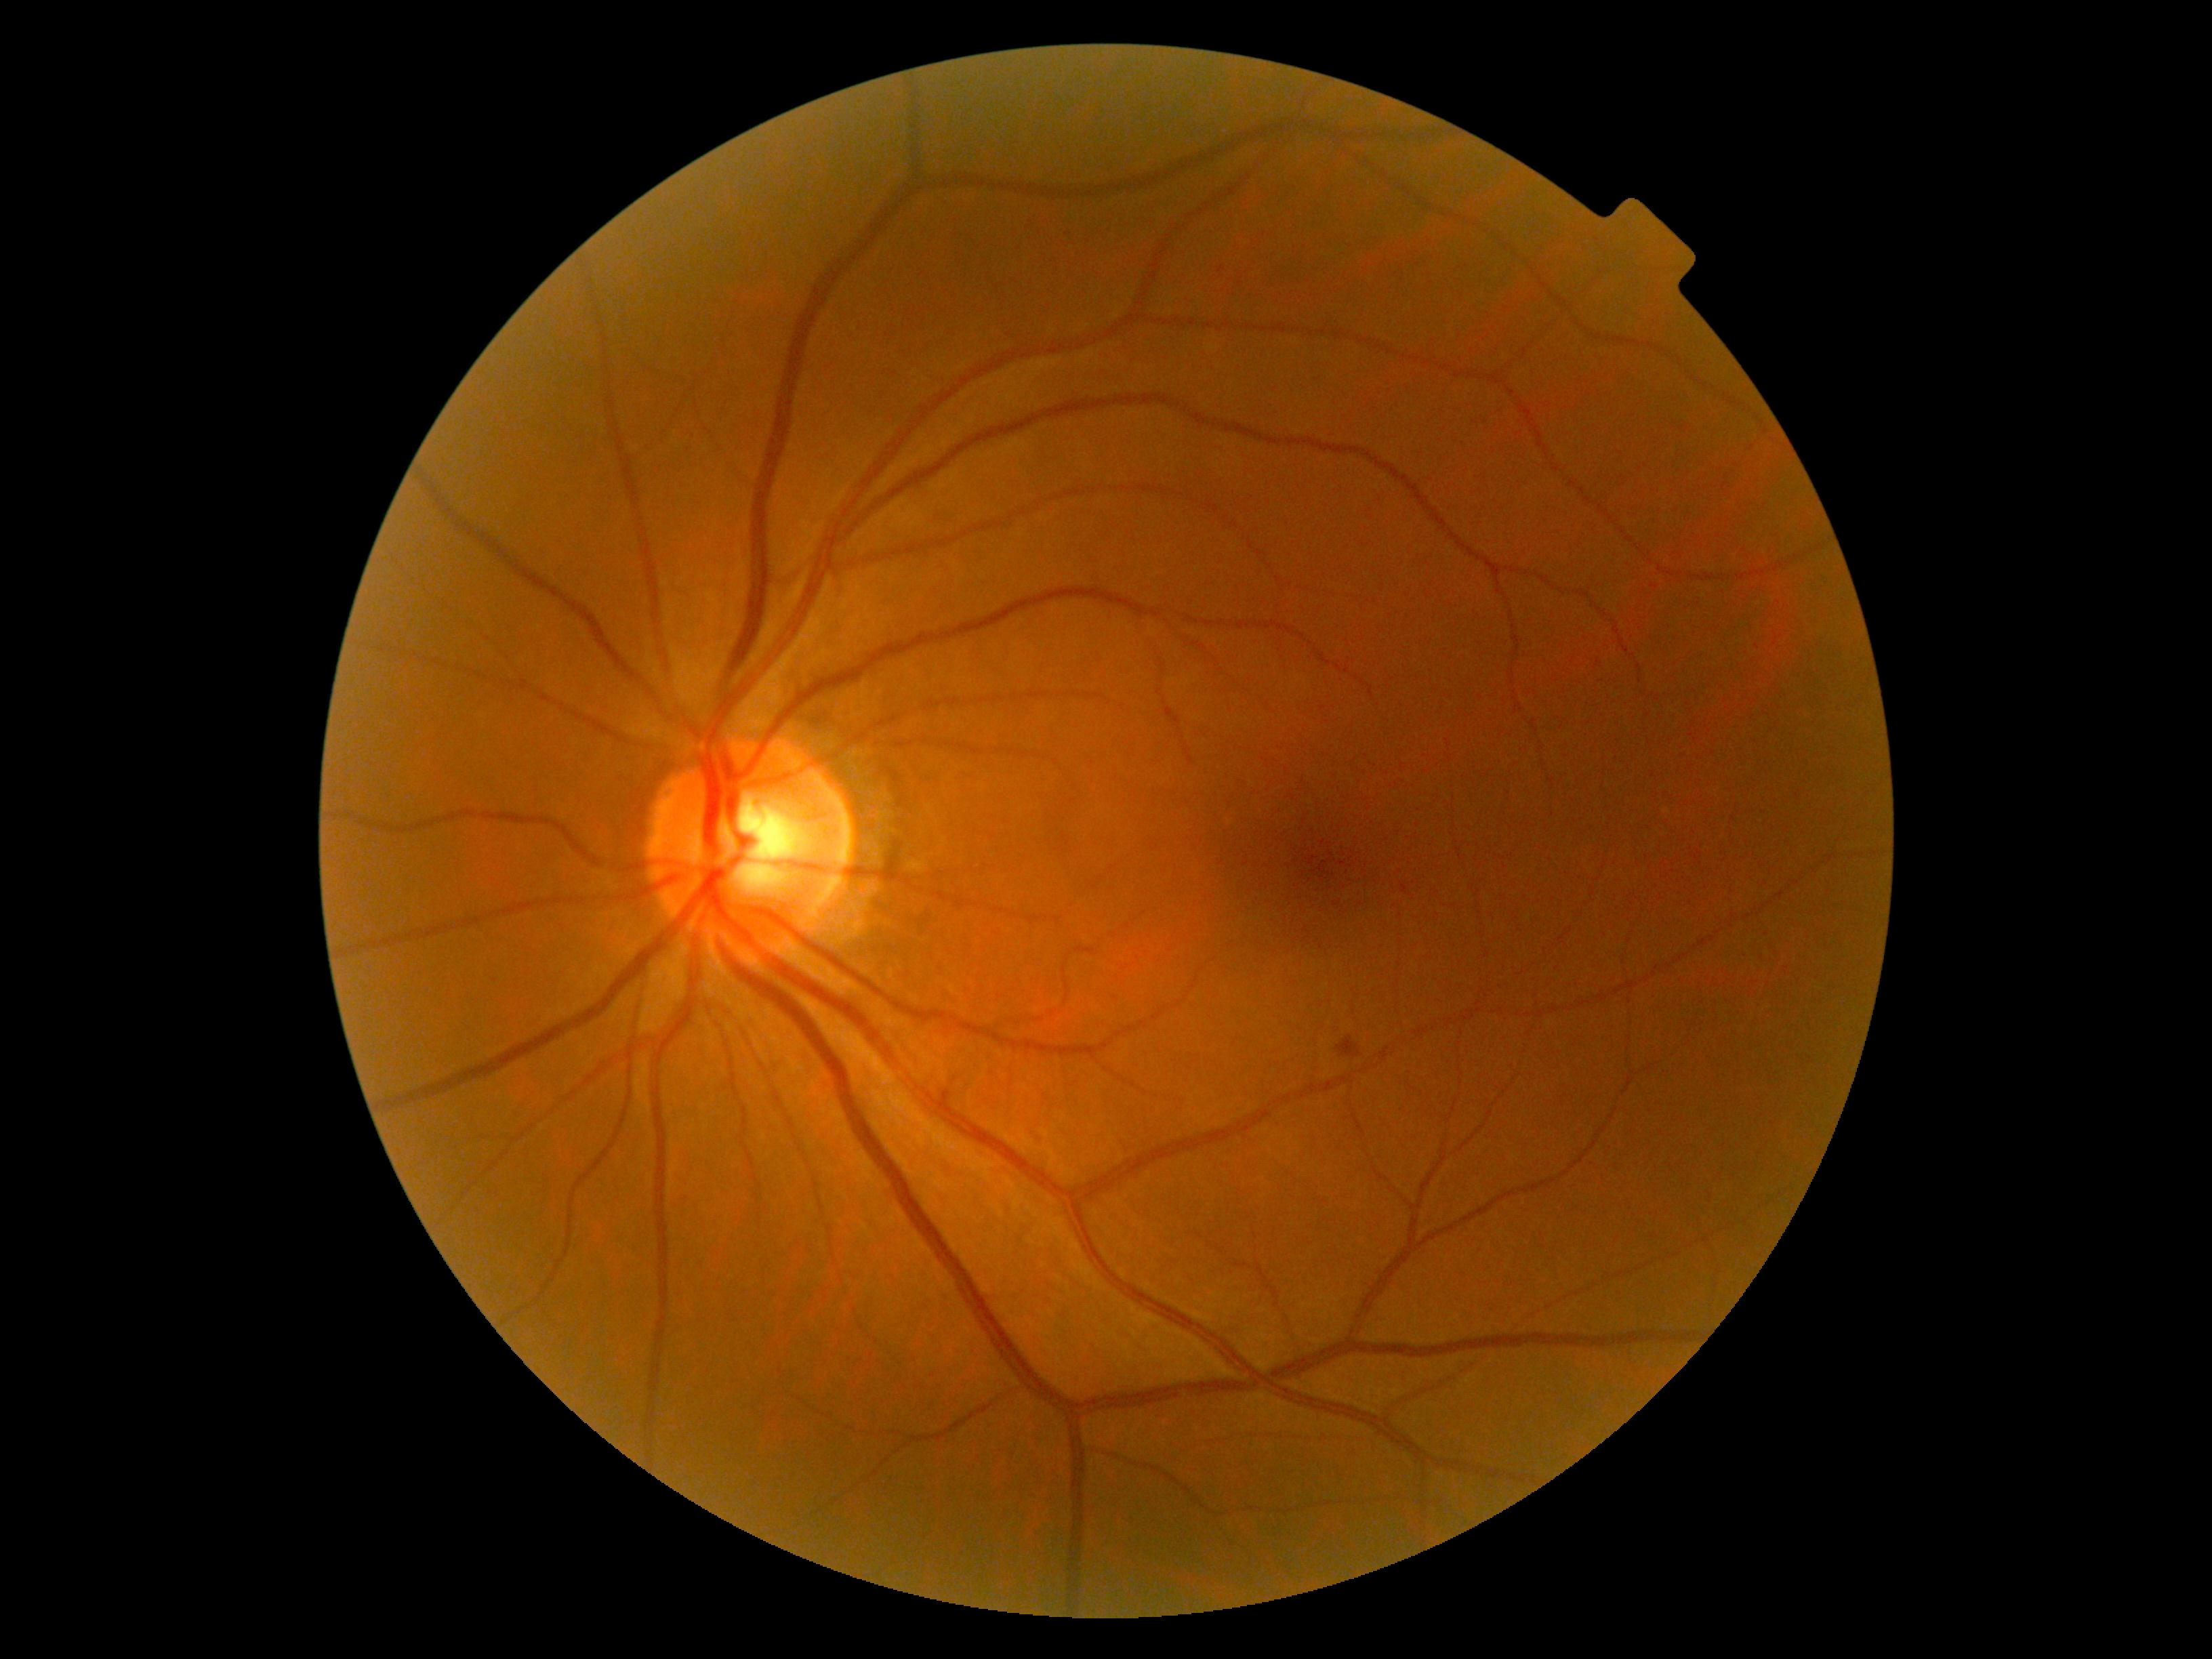

diabetic retinopathy (DR)@moderate NPDR (grade 2).